45° FOV: 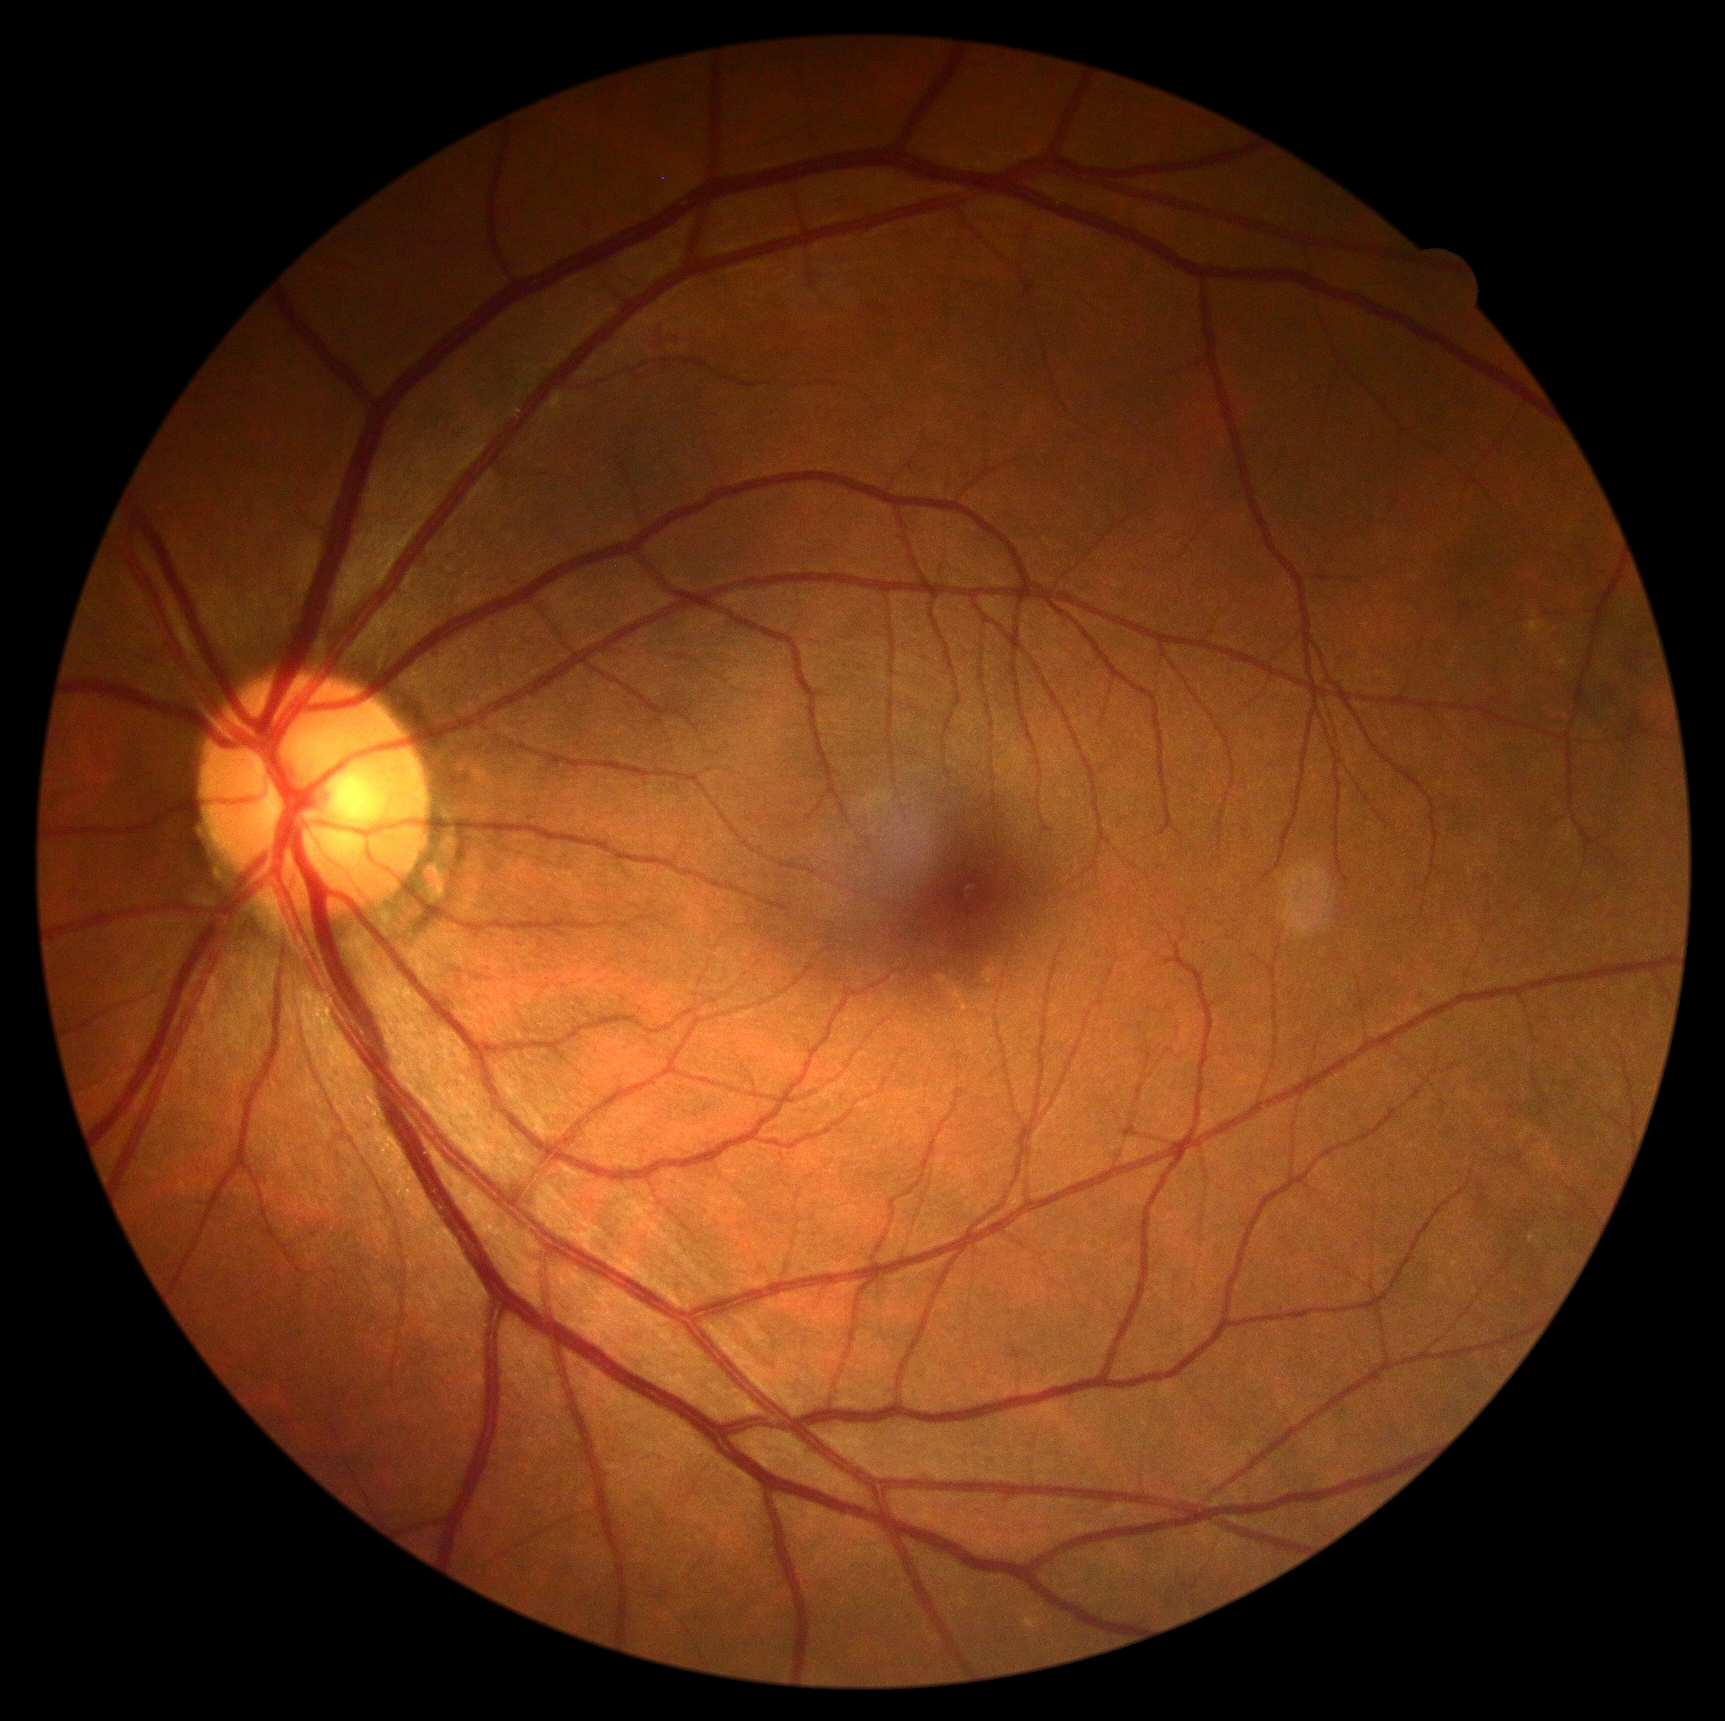 Annotations:
* DR: grade 0 (no apparent retinopathy) — no visible signs of diabetic retinopathy